Camera: Clarity RetCam 3 (130° FOV). Wide-field fundus image from infant ROP screening.
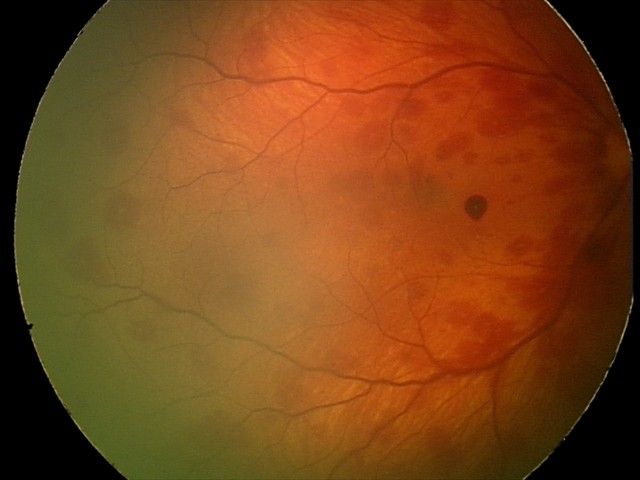
Q: What is the diagnosis from this examination?
A: retinal hemorrhages